2352 by 1568 pixels — 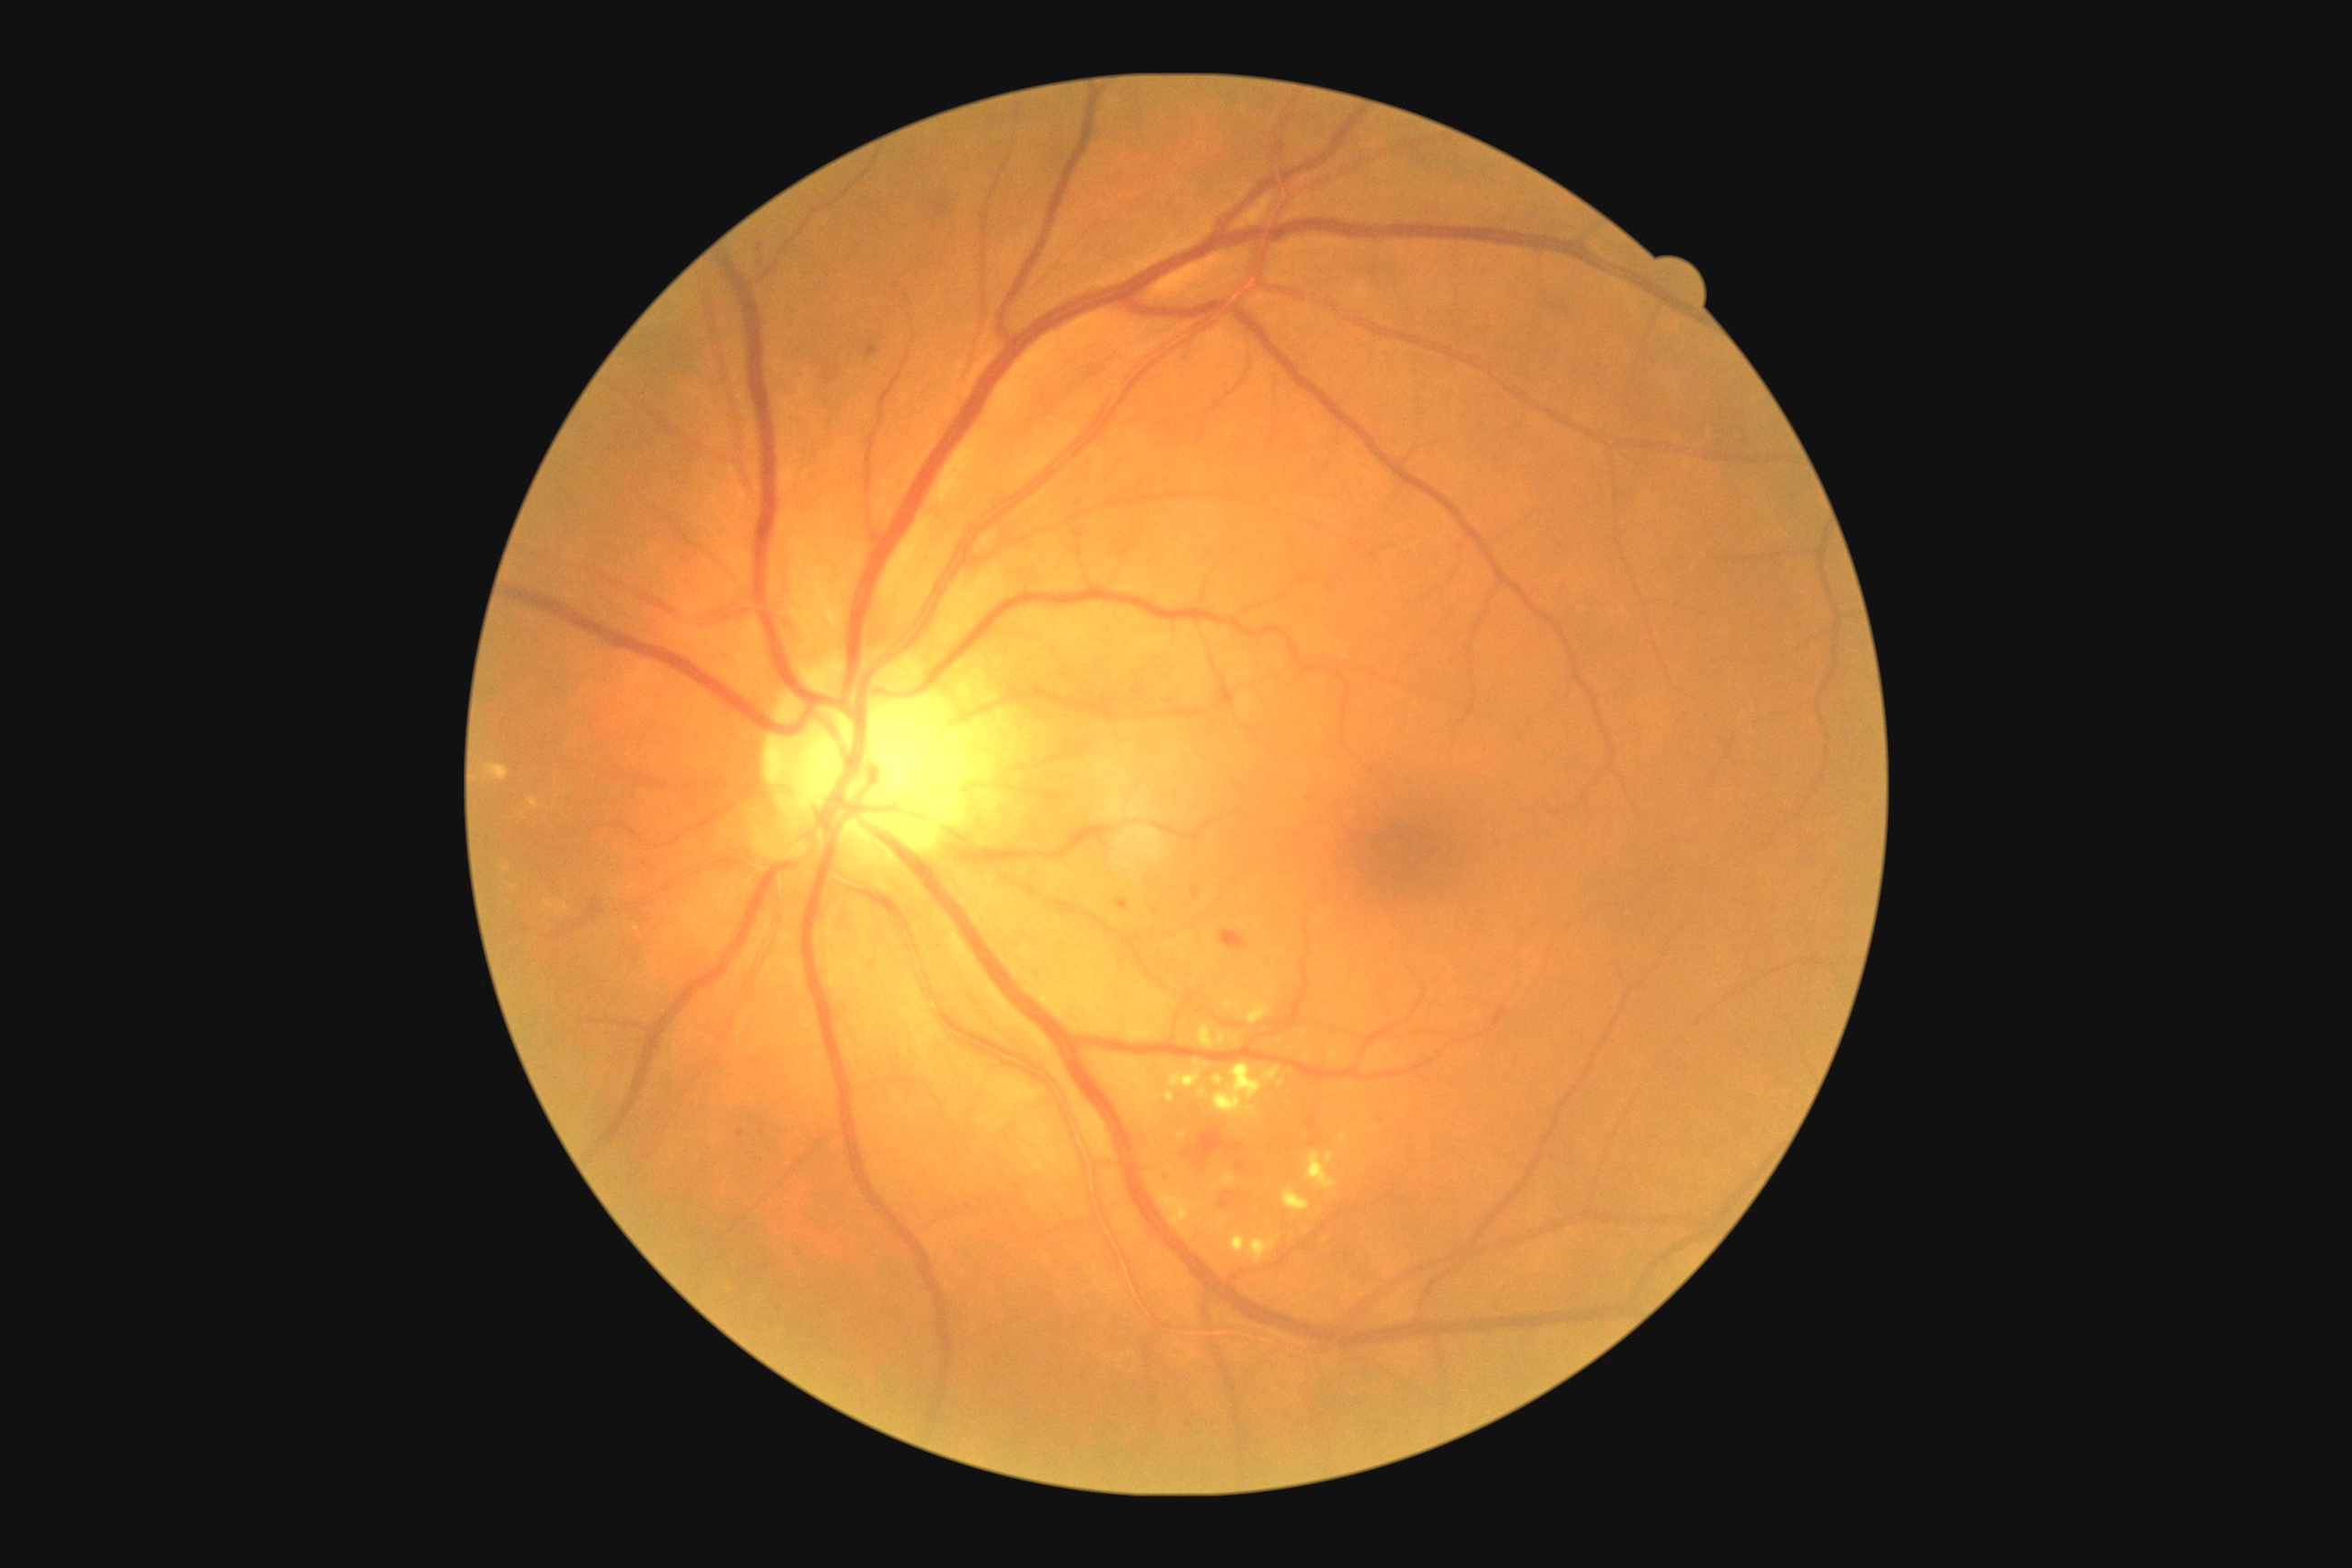

DR: grade 2 — more than just microaneurysms but less than severe NPDR
A subset of detected lesions:
EXs (continued): [1304,1052,1311,1063] | [1231,1235,1280,1264] | [1248,999,1271,1024] | [1224,995,1244,1015] | [1282,1188,1311,1213] | [1340,1133,1348,1142] | [1179,1132,1188,1141] | [1199,1088,1208,1099] | [1199,1024,1213,1048] | [1168,1204,1179,1215] | [1213,1075,1226,1088]
Smaller EXs around x=1207, y=1066 | x=1290, y=1071 | x=1280, y=1040